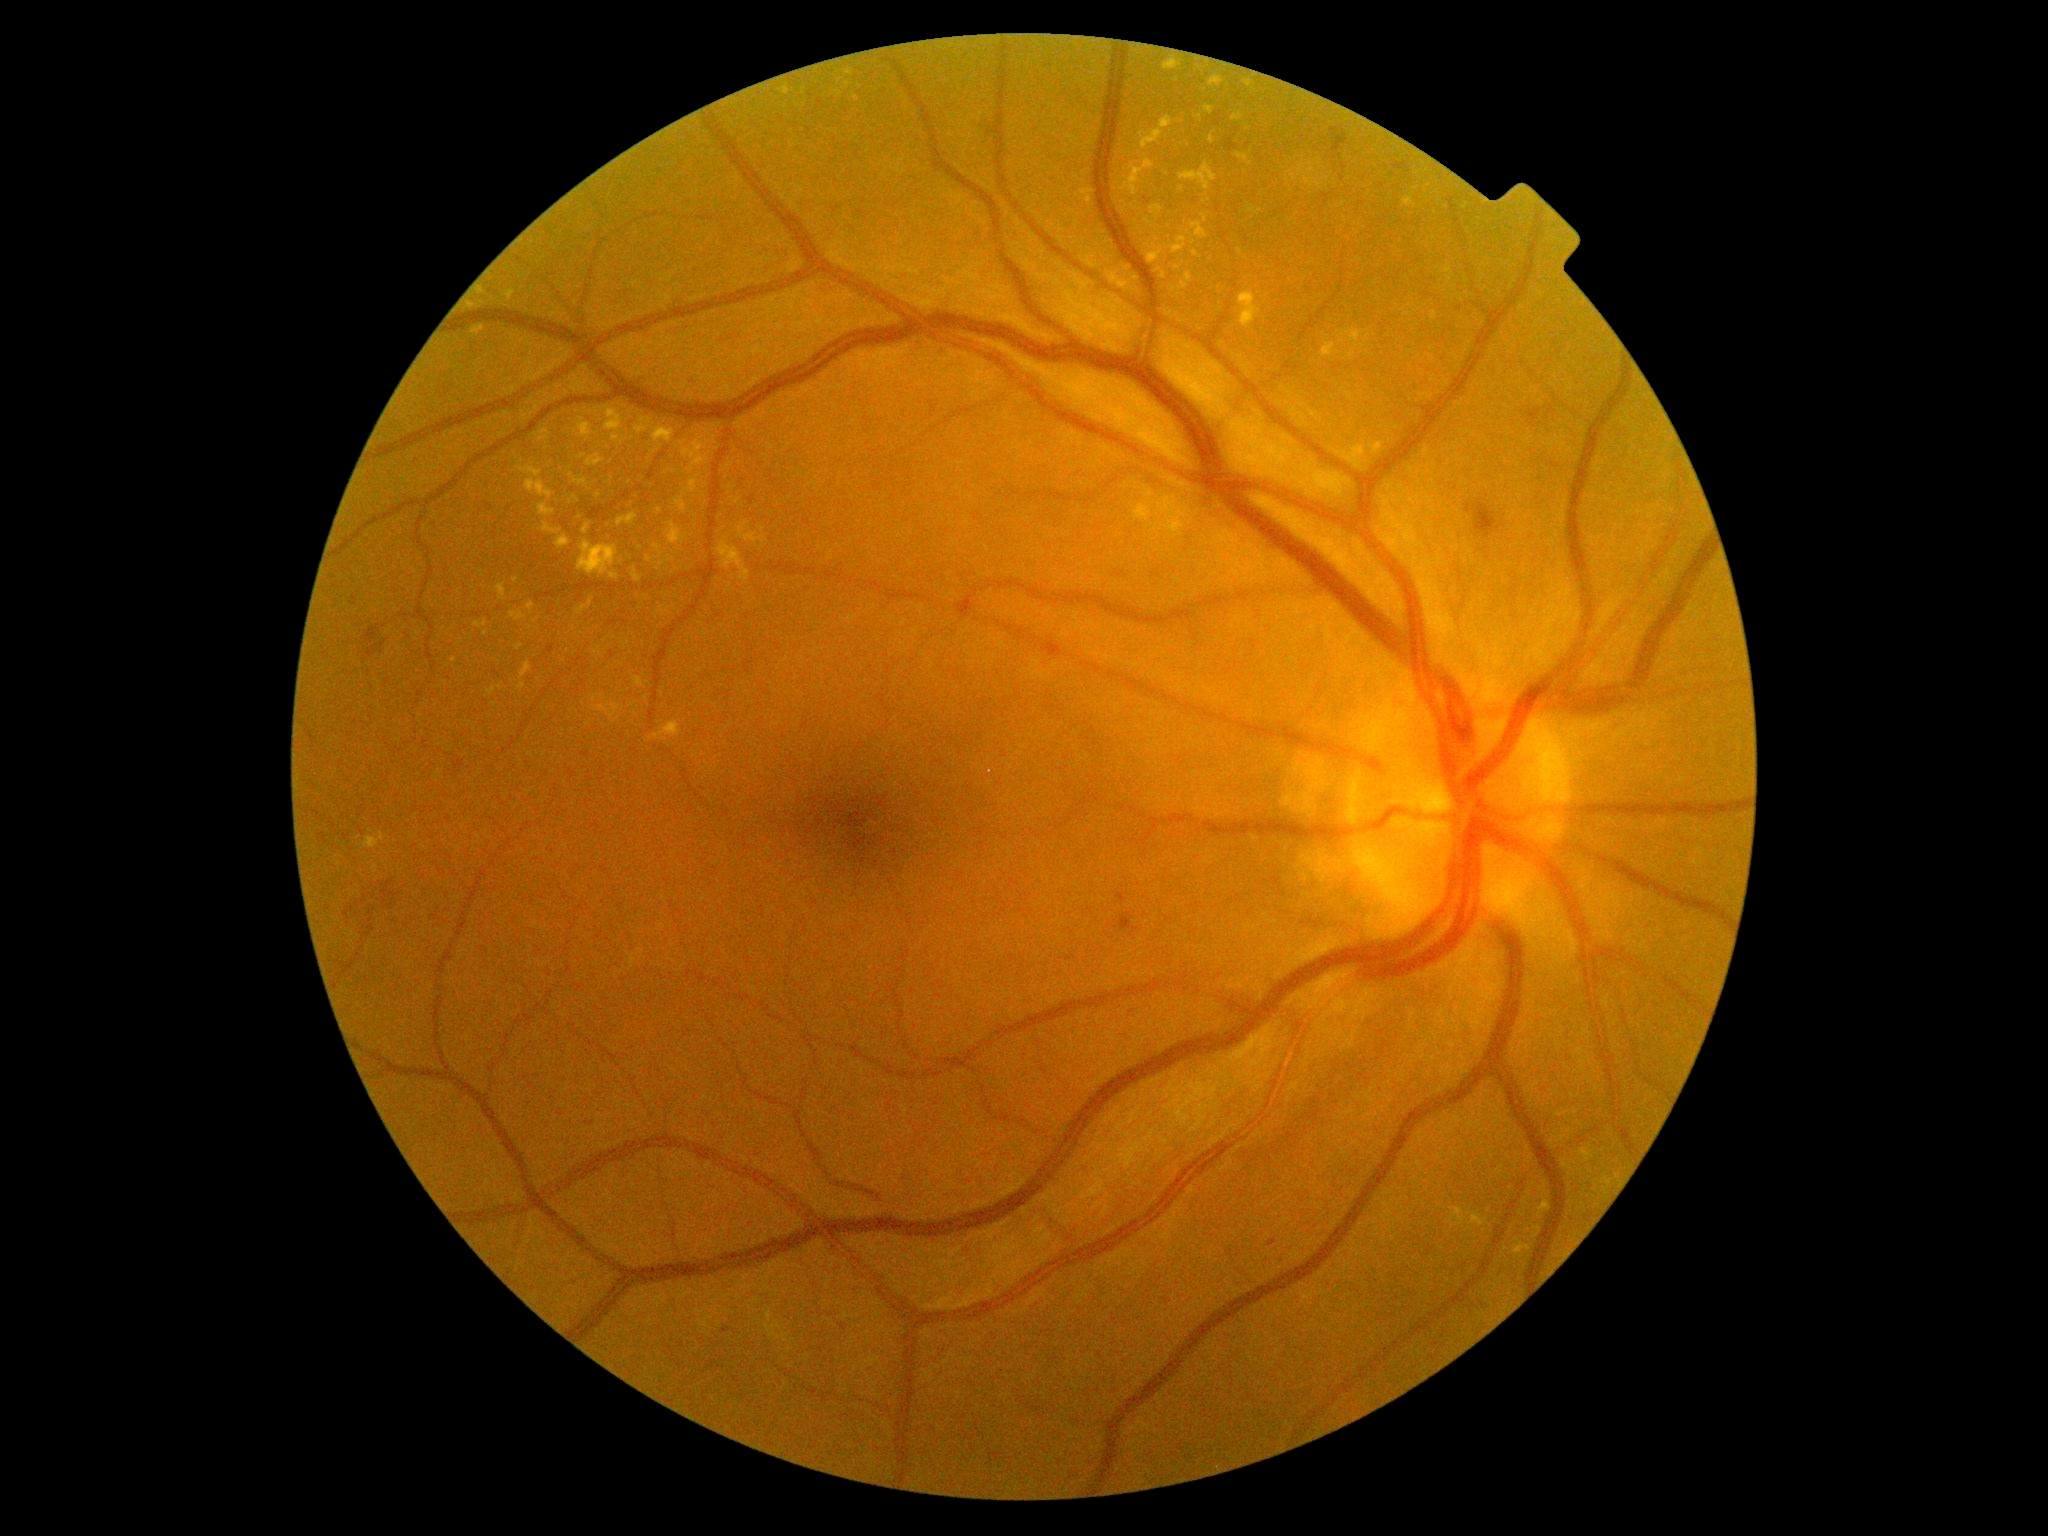

{"partial": true, "dr_grade": 2, "lesions": {"ex": [[605, 407, 624, 445], [667, 522, 686, 547], [574, 496, 581, 504], [1150, 205, 1165, 219], [1120, 159, 1156, 197], [1190, 222, 1208, 241], [465, 301, 477, 311], [700, 426, 713, 439], [680, 440, 688, 446], [587, 453, 605, 468], [1533, 1227, 1542, 1239], [782, 86, 790, 96]], "ex_small_centers": [[646, 698], [1529, 1230], [482, 303], [804, 90], [650, 422], [1194, 243], [1240, 252], [1301, 172]]}}